Retinal fundus photograph
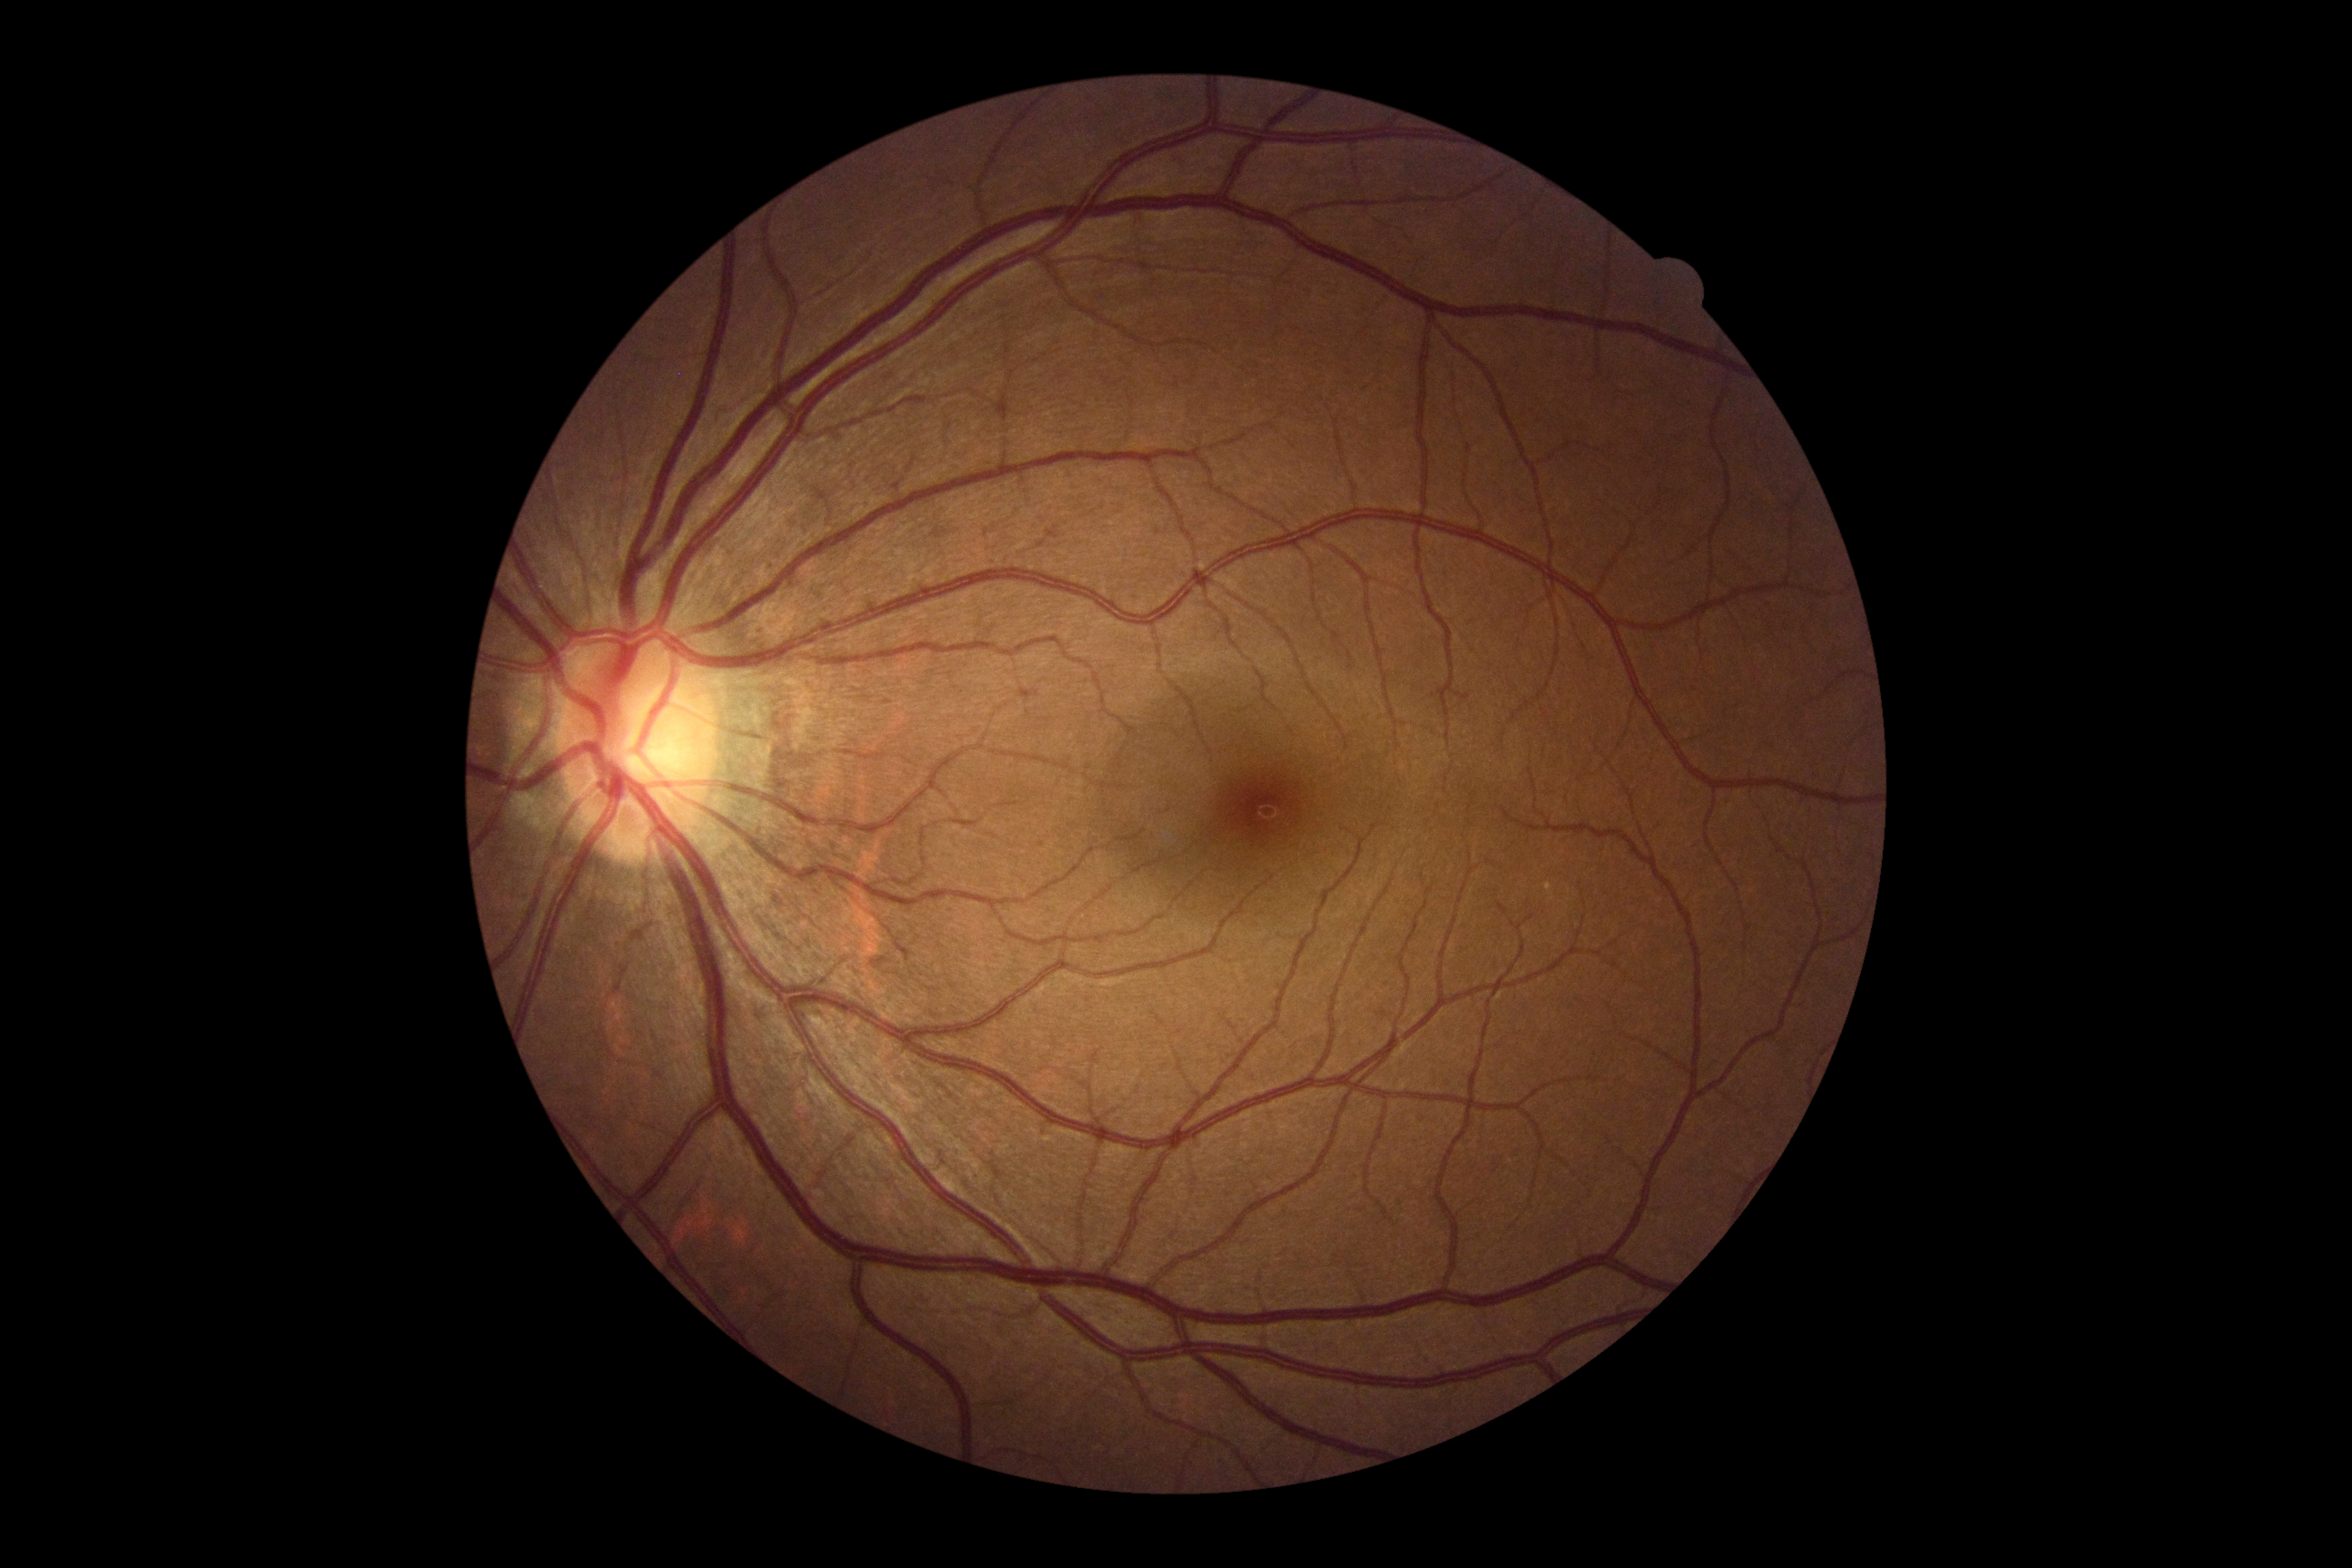
No signs of diabetic retinopathy.
DR is 0/4.